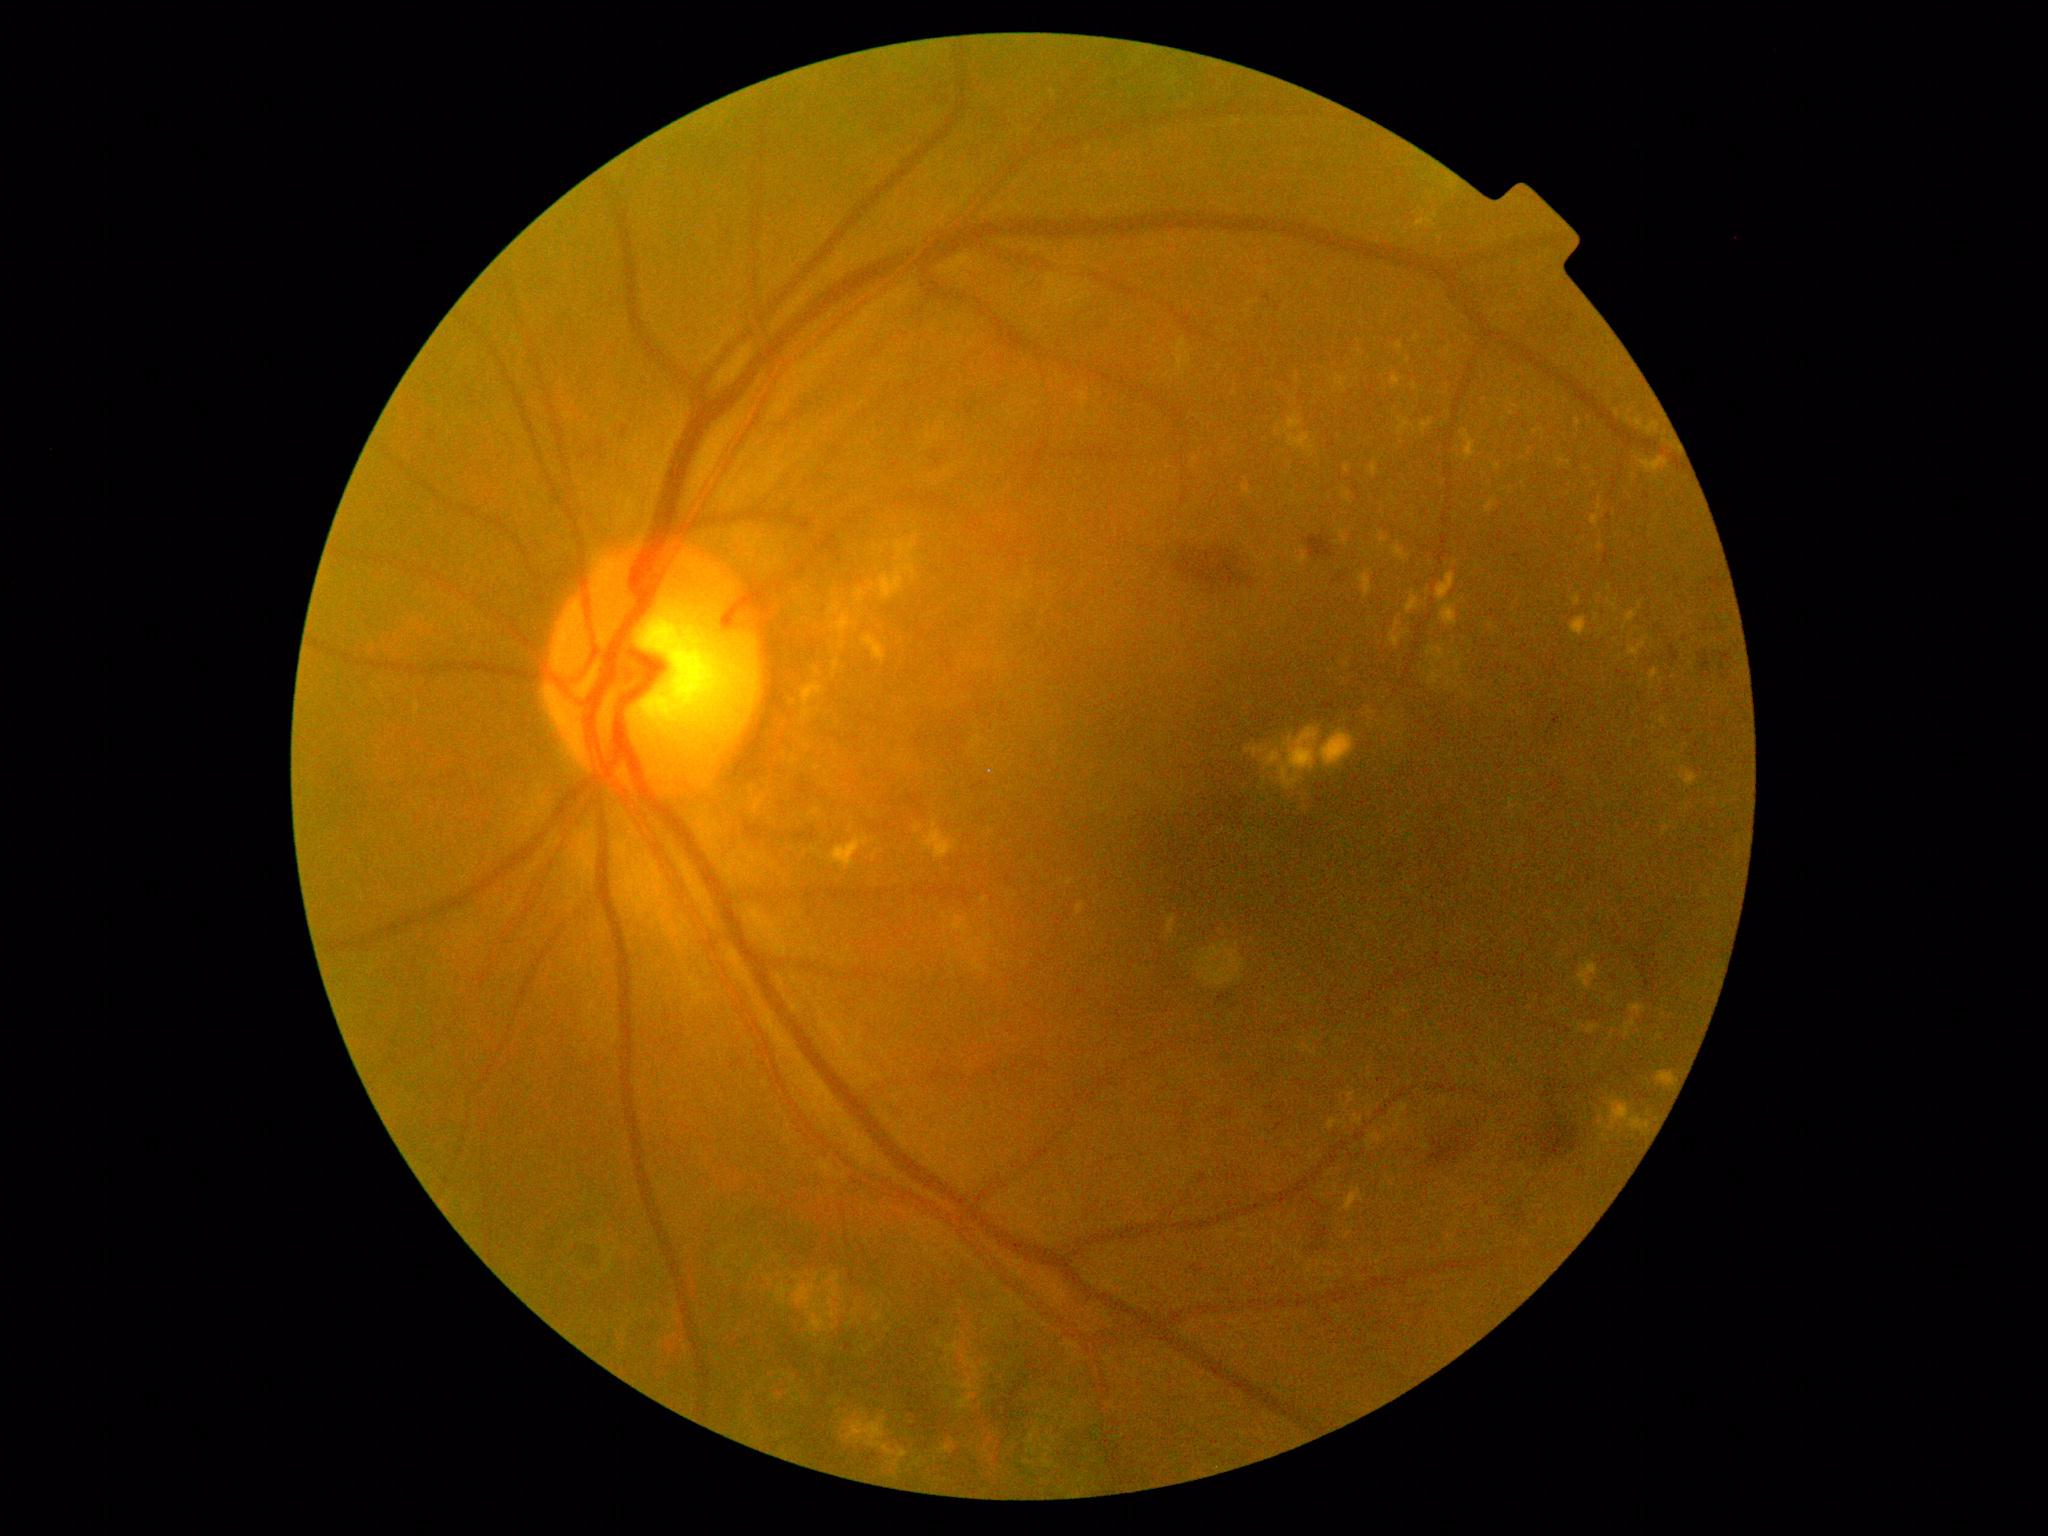 {"partial": true, "dr_grade": 2, "lesions": {"ex": [[1244, 484, 1252, 495], [950, 915, 969, 936], [811, 682, 825, 700], [1557, 457, 1572, 468], [854, 588, 868, 604], [1588, 1022, 1602, 1035], [1595, 614, 1599, 623], [1633, 418, 1661, 435], [1396, 342, 1404, 351], [1393, 543, 1410, 561], [1436, 573, 1457, 603], [1298, 553, 1308, 566], [1076, 902, 1085, 915], [830, 836, 871, 869]], "ex_small": [[1625, 628], [882, 551], [1601, 546], [1346, 1108]]}}